Camera: Bosch fundus camera.
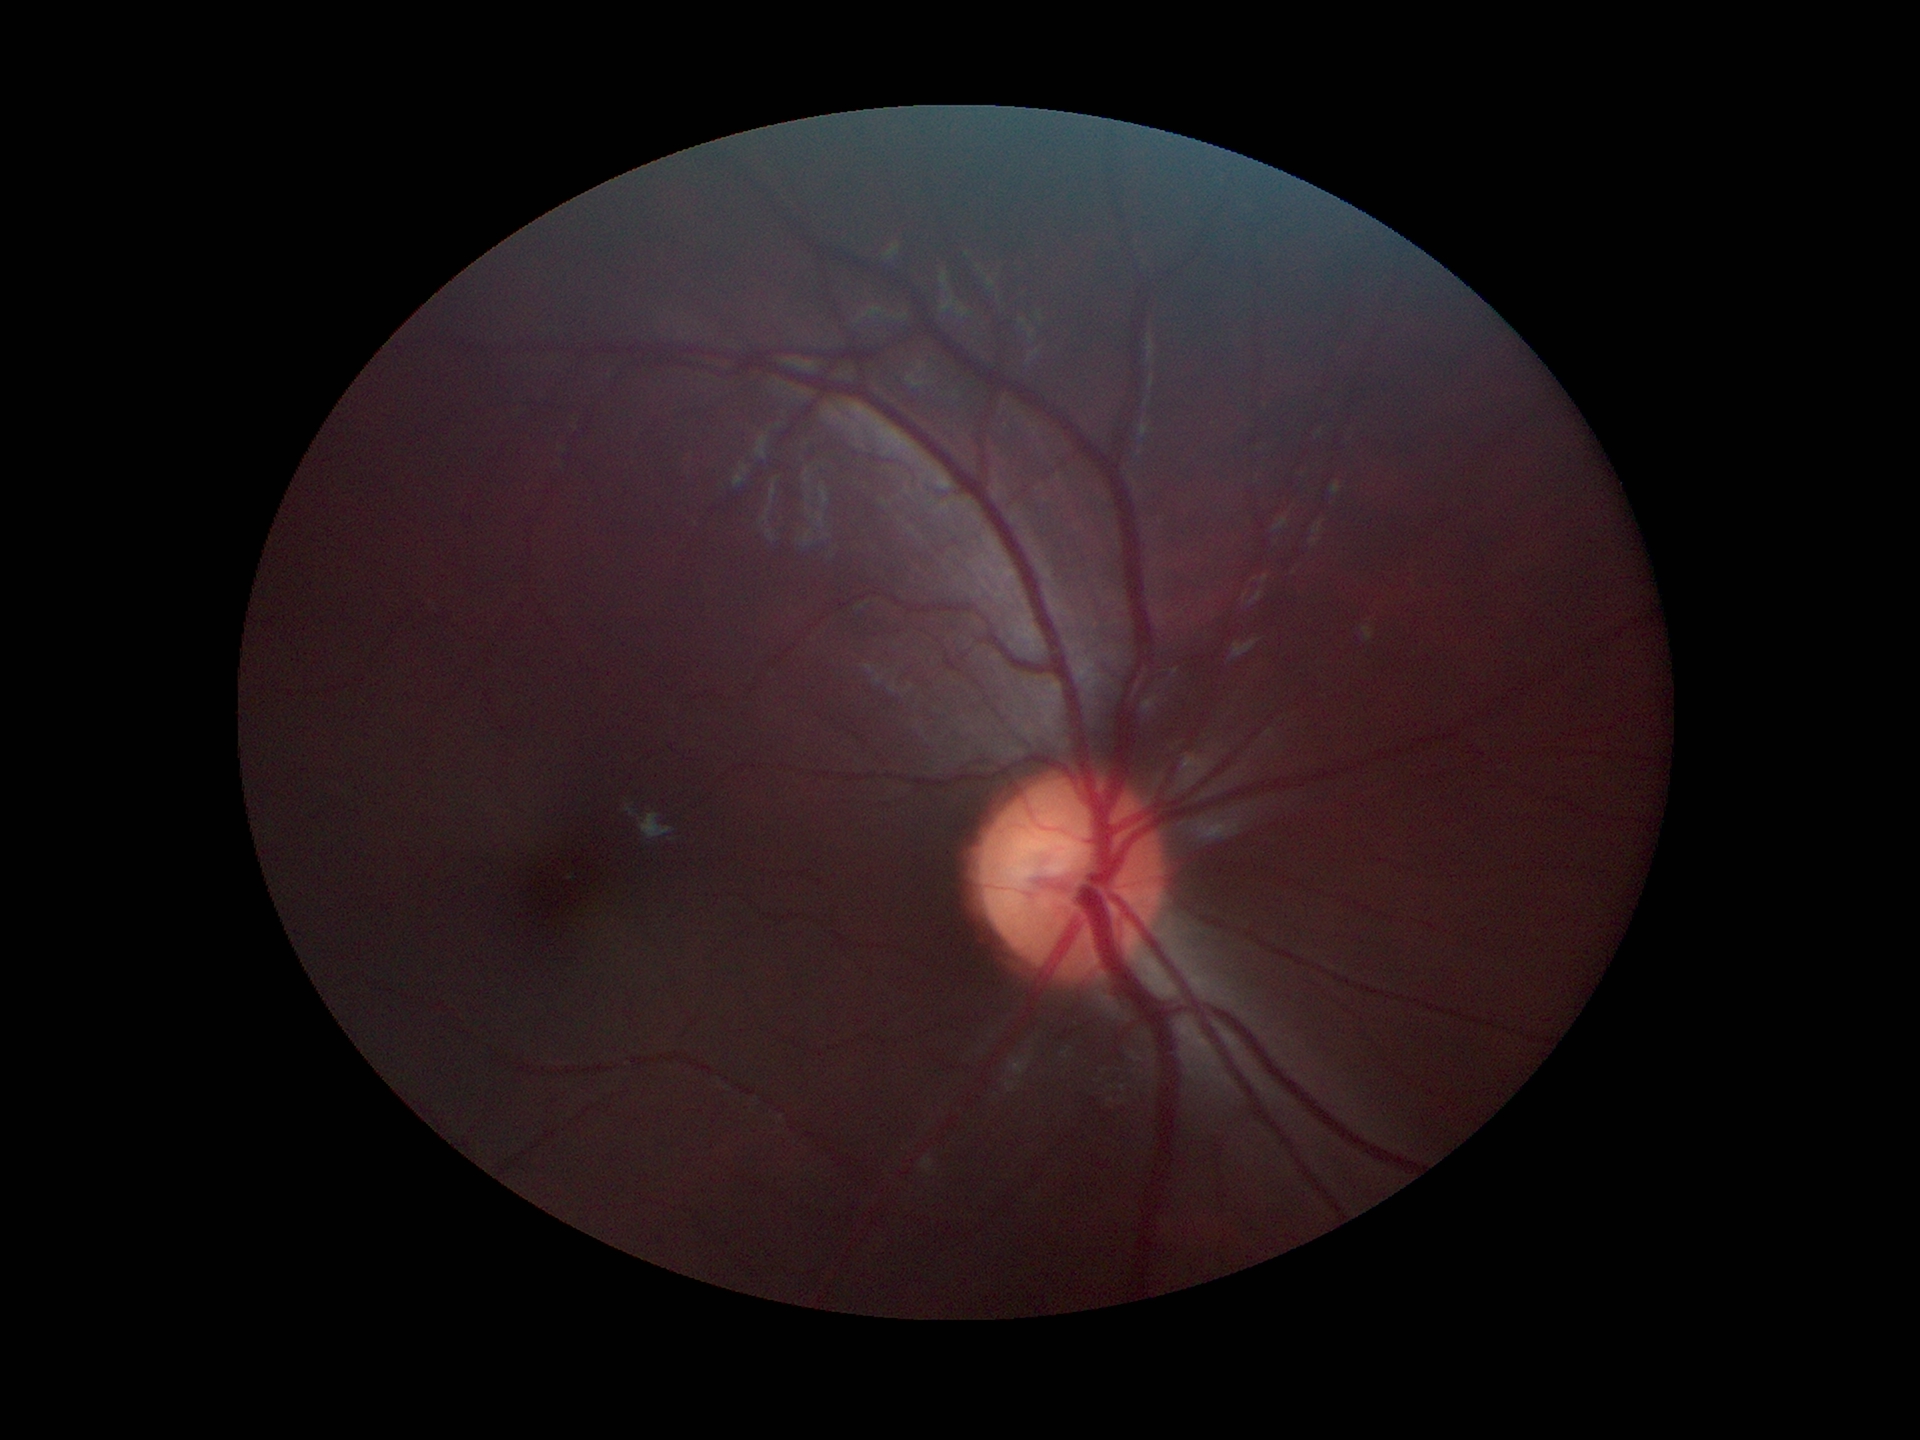

HCDR = 0.53, VCDR = 0.48, Glaucoma screening impression = not suspect.